640 by 480 pixels; wide-field fundus photograph of an infant: 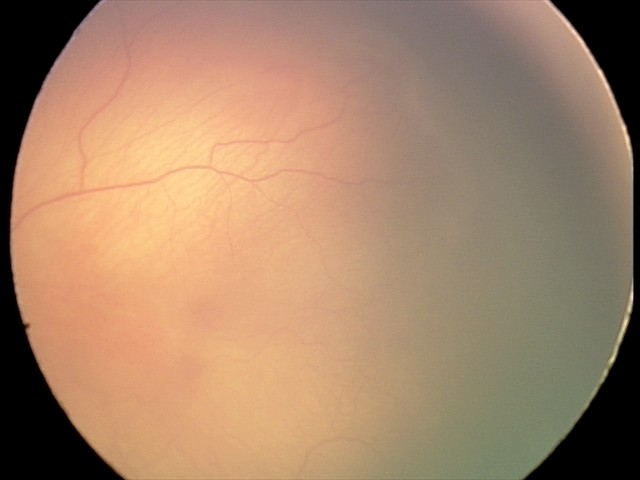

Examination diagnosed as retinopathy of prematurity (ROP) stage 1.